Wide-field fundus photograph of an infant. 1240 by 1240 pixels — 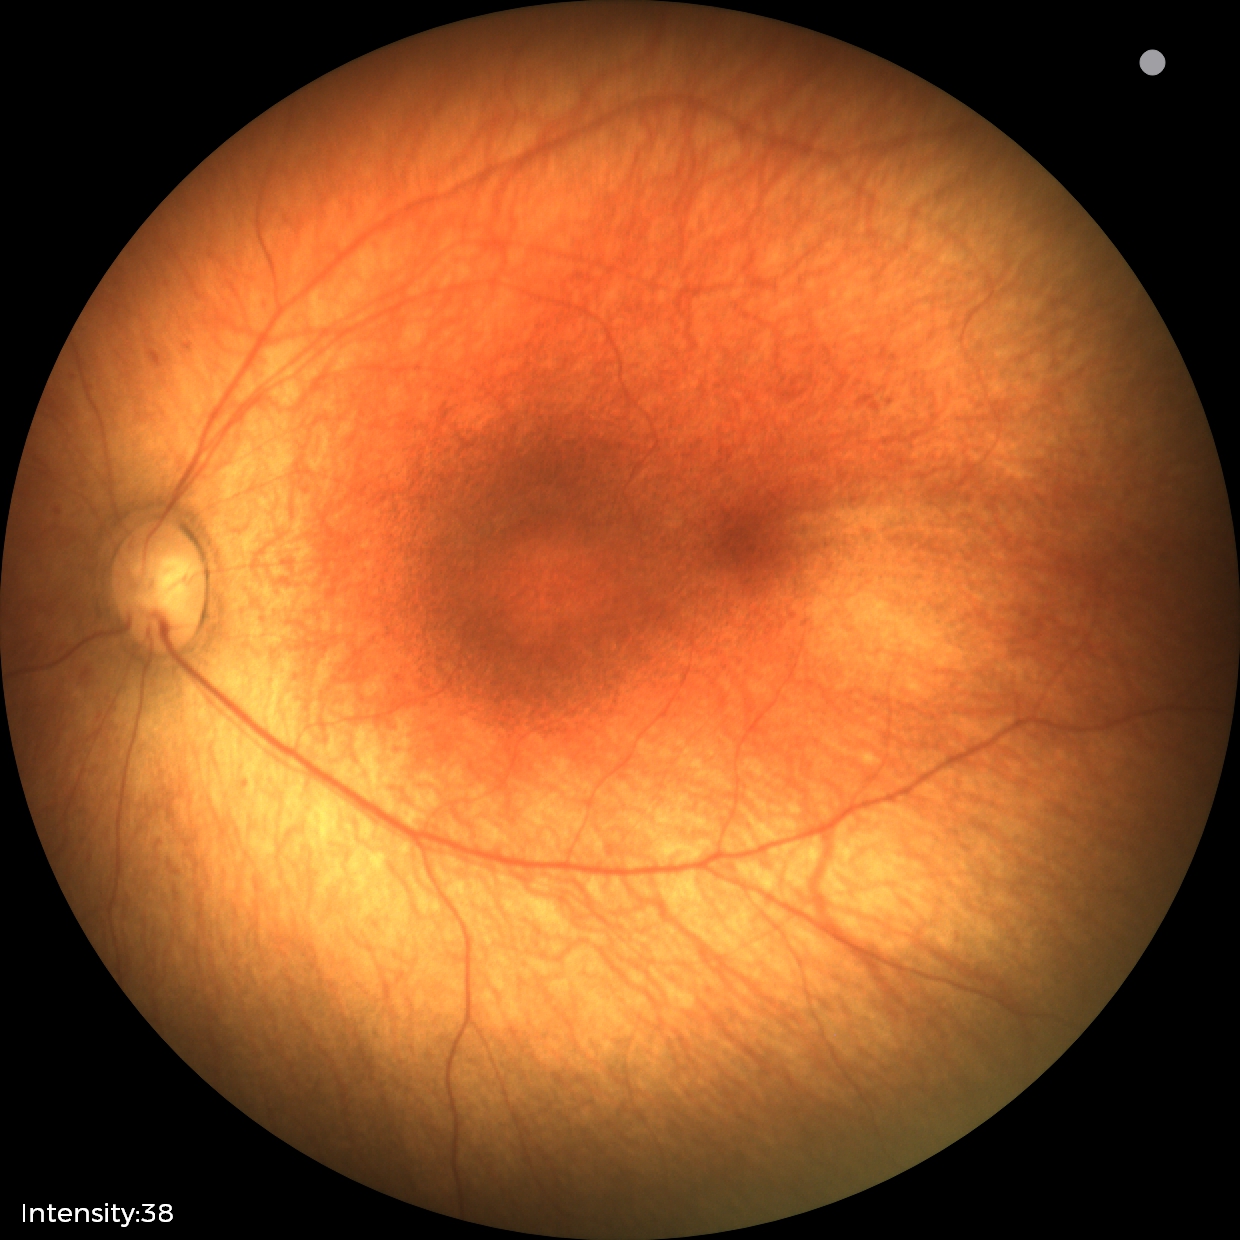

No retinal pathology identified on screening.